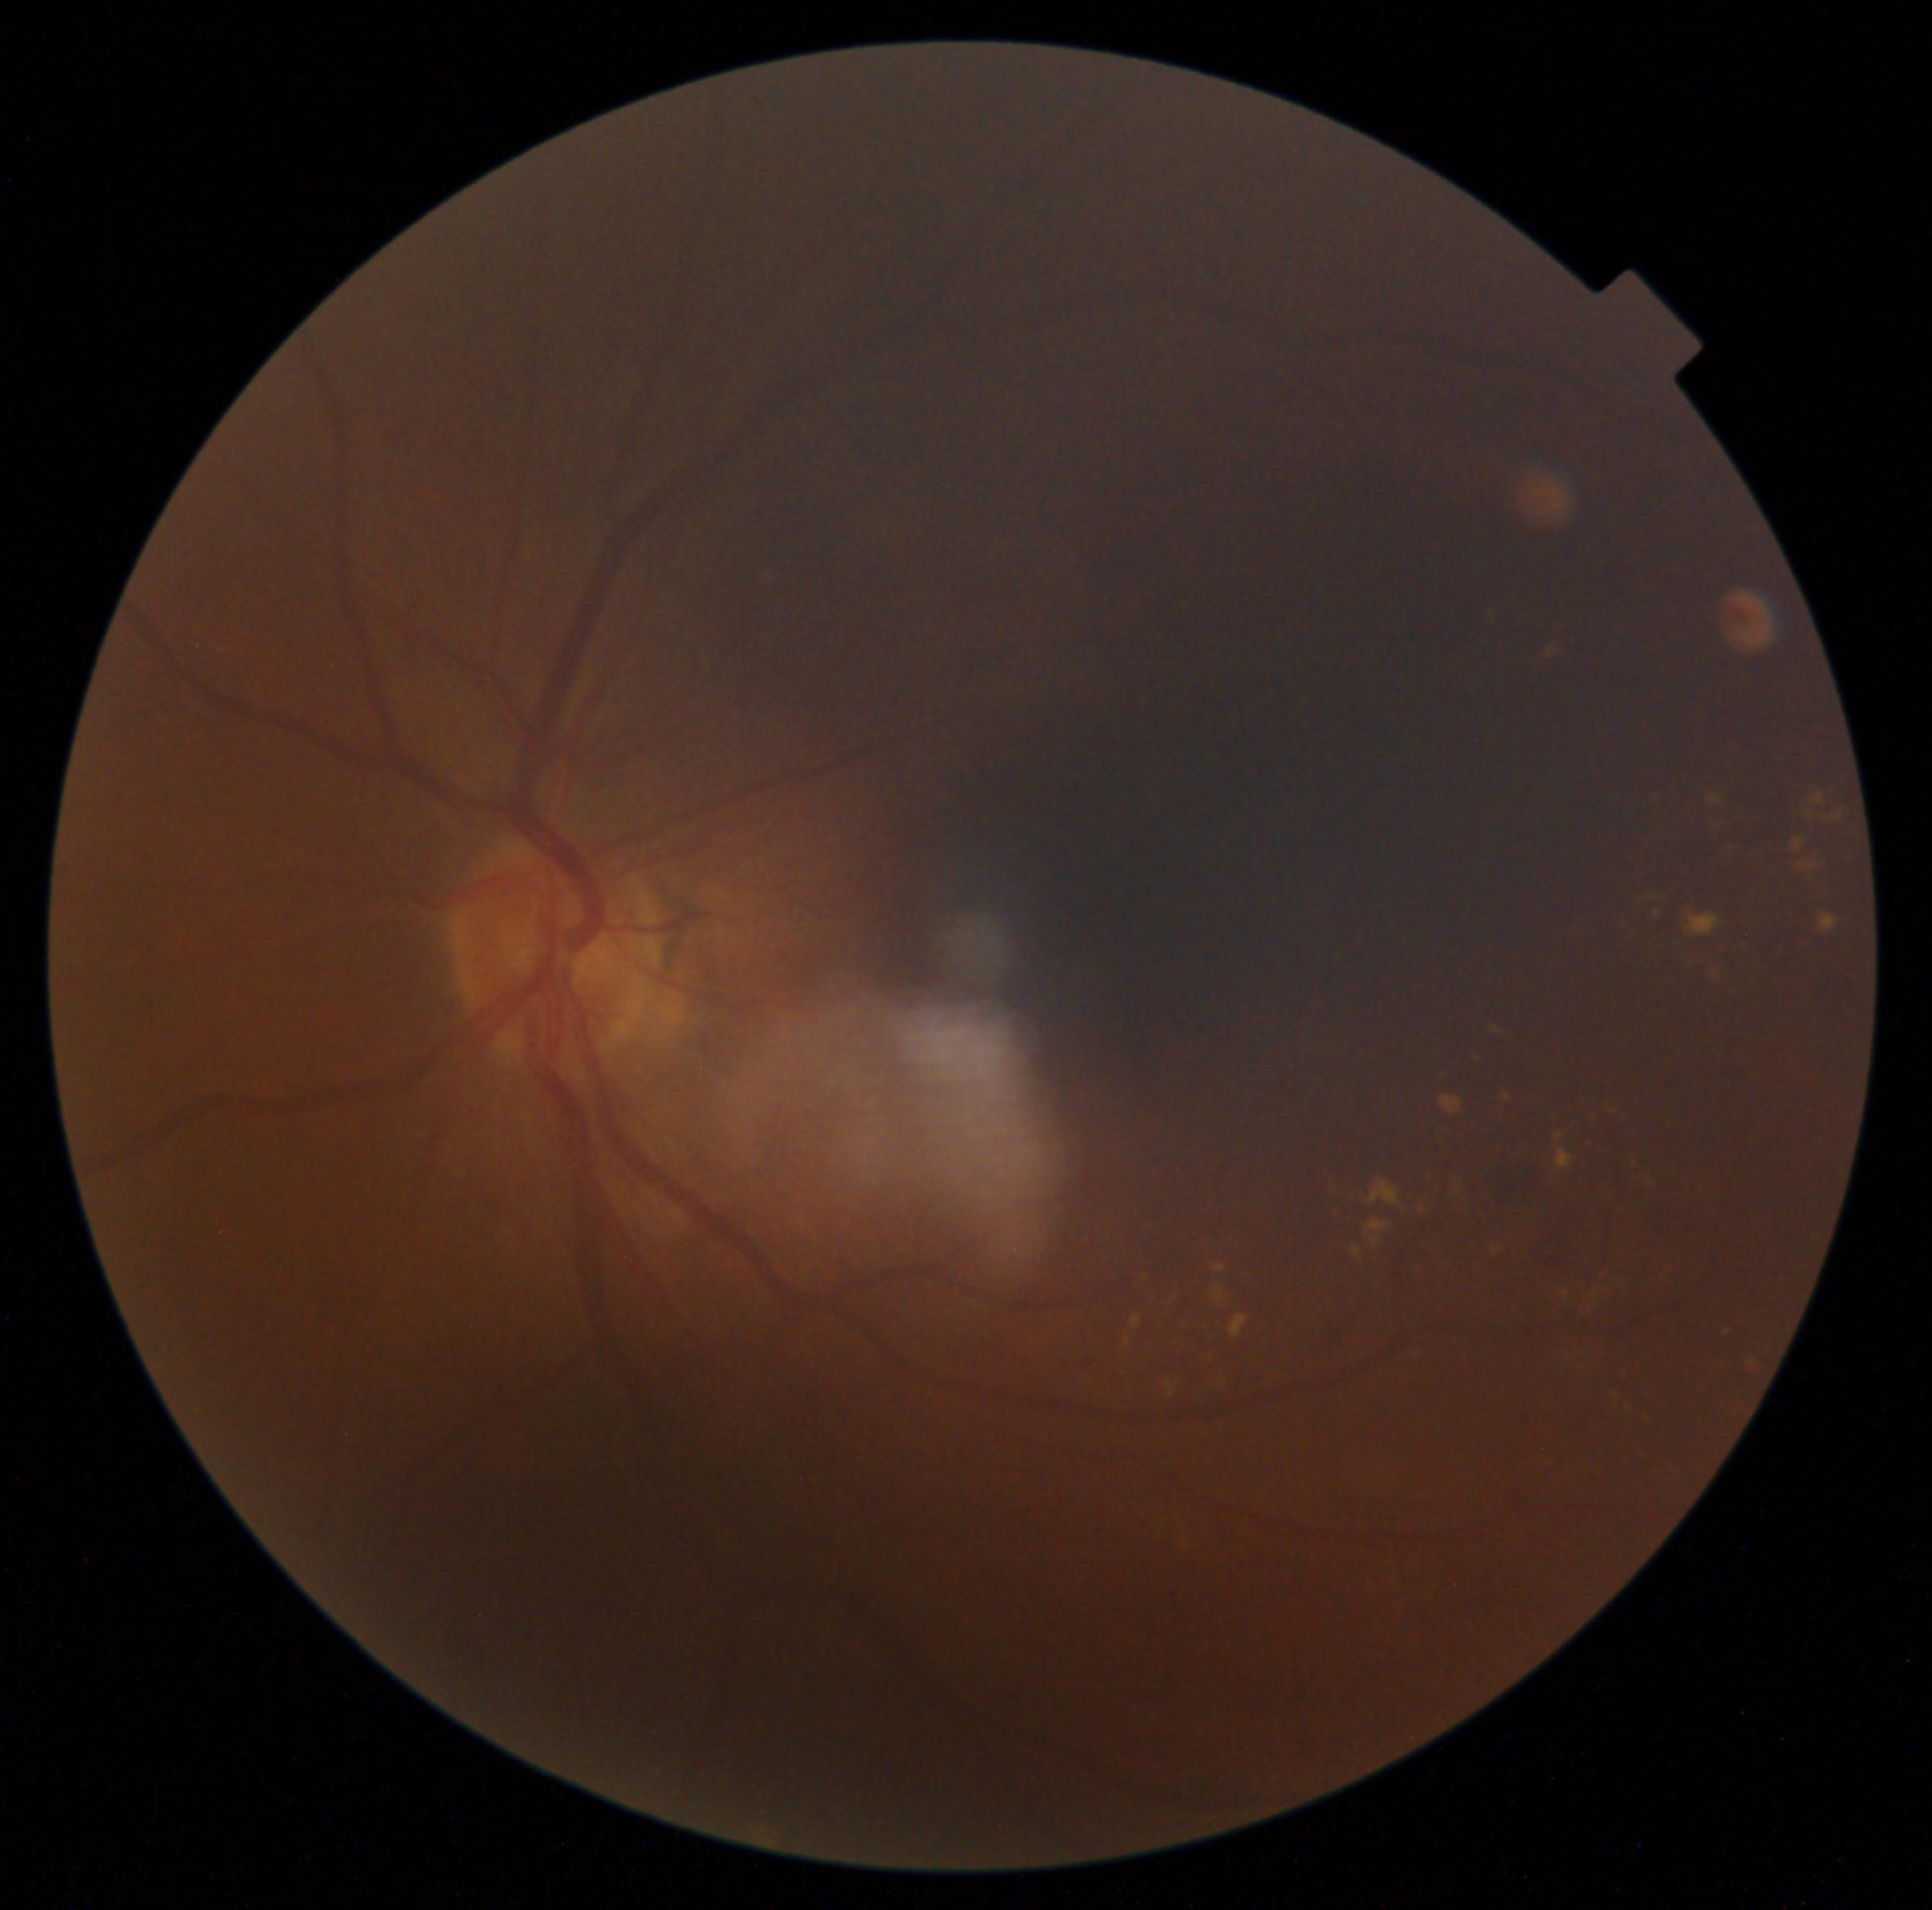

Diabetic retinopathy (DR) is grade 2 (moderate NPDR)
Selected lesions:
hard exudates (EXs) (more not shown): 1834/813/1845/820; 1132/1316/1142/1329; 1167/1381/1176/1398; 1414/1191/1427/1216; 1214/1266/1227/1273; 1683/951/1723/987; 1332/1178/1357/1204; 1493/1028/1502/1035; 1748/1356/1760/1372; 1702/1385/1716/1397; 1354/1246/1363/1257; 1142/1277/1153/1295; 1167/1290/1178/1311; 1366/1222/1392/1235; 1441/1096/1463/1116; 1636/1407/1658/1433; 1557/1136/1566/1141; 1207/1349/1216/1365
EXs (small, approximate centers) near 1567:1295